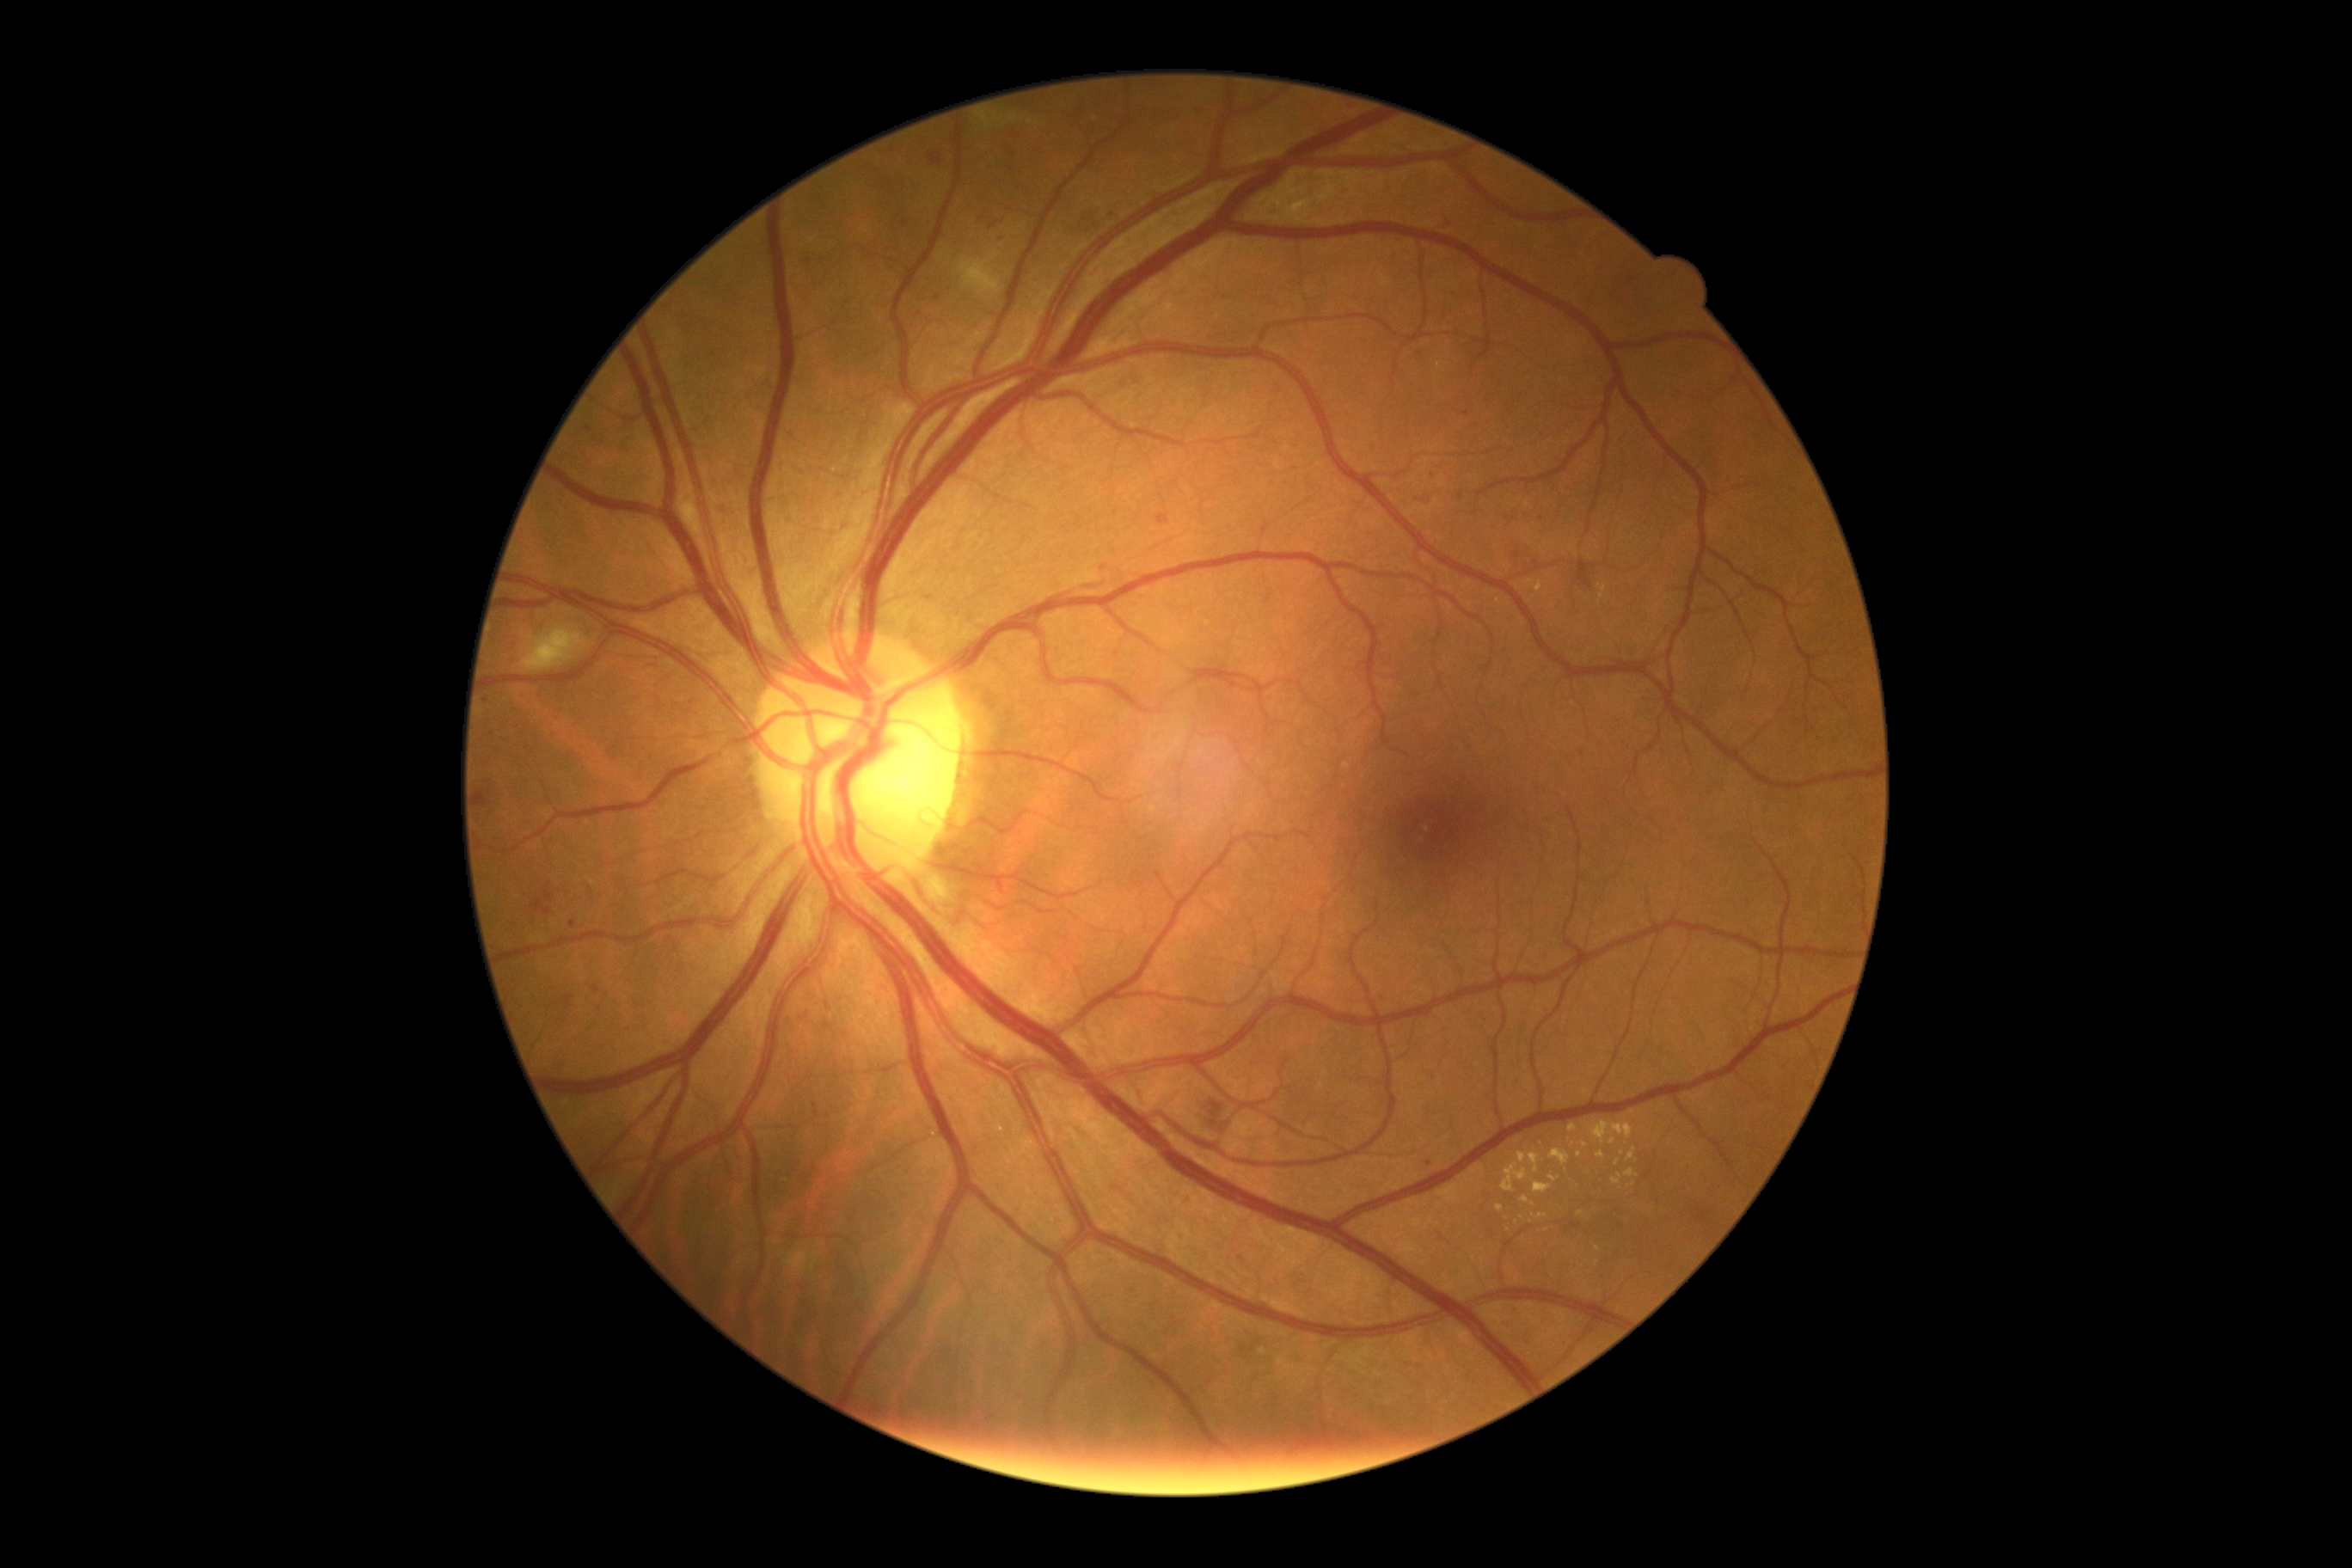
Diabetic retinopathy (DR) is grade 2; non-proliferative diabetic retinopathy
Selected lesions:
soft exudates (SEs) = (520,627,589,673) | (955,254,1001,297)
hemorrhages (HEs) = (1203,1094,1232,1132) | (479,792,491,807) | (1574,560,1596,589) | (479,818,487,833) | (1070,209,1091,236)
hard exudates (EXs) (continued) = (680,489,697,518) | (1593,1122,1634,1146) | (1608,1137,1617,1146) | (1596,1151,1607,1160) | (1550,1175,1559,1182) | (1497,1204,1505,1211) | (1529,1151,1541,1173) | (1517,1153,1528,1165) | (1627,1149,1638,1161)
Additional small EXs near x=1580 y=1154 | x=1532 y=1205 | x=1617 y=1163 | x=1567 y=1170 | x=1597 y=1250
microaneurysms (MAs) (continued) = (570,921,577,929) | (931,154,943,166) | (534,900,551,916) | (1459,493,1464,501) | (805,259,814,267) | (1514,551,1522,560) | (592,984,601,995) | (1156,515,1170,525) | (1418,496,1436,506) | (685,494,692,503)
Additional small MAs near x=1421 y=1367 | x=1410 y=1366 | x=863 y=401 | x=1621 y=1227 | x=906 y=225 | x=1429 y=1165 | x=588 y=633 | x=1002 y=239 | x=1104 y=568